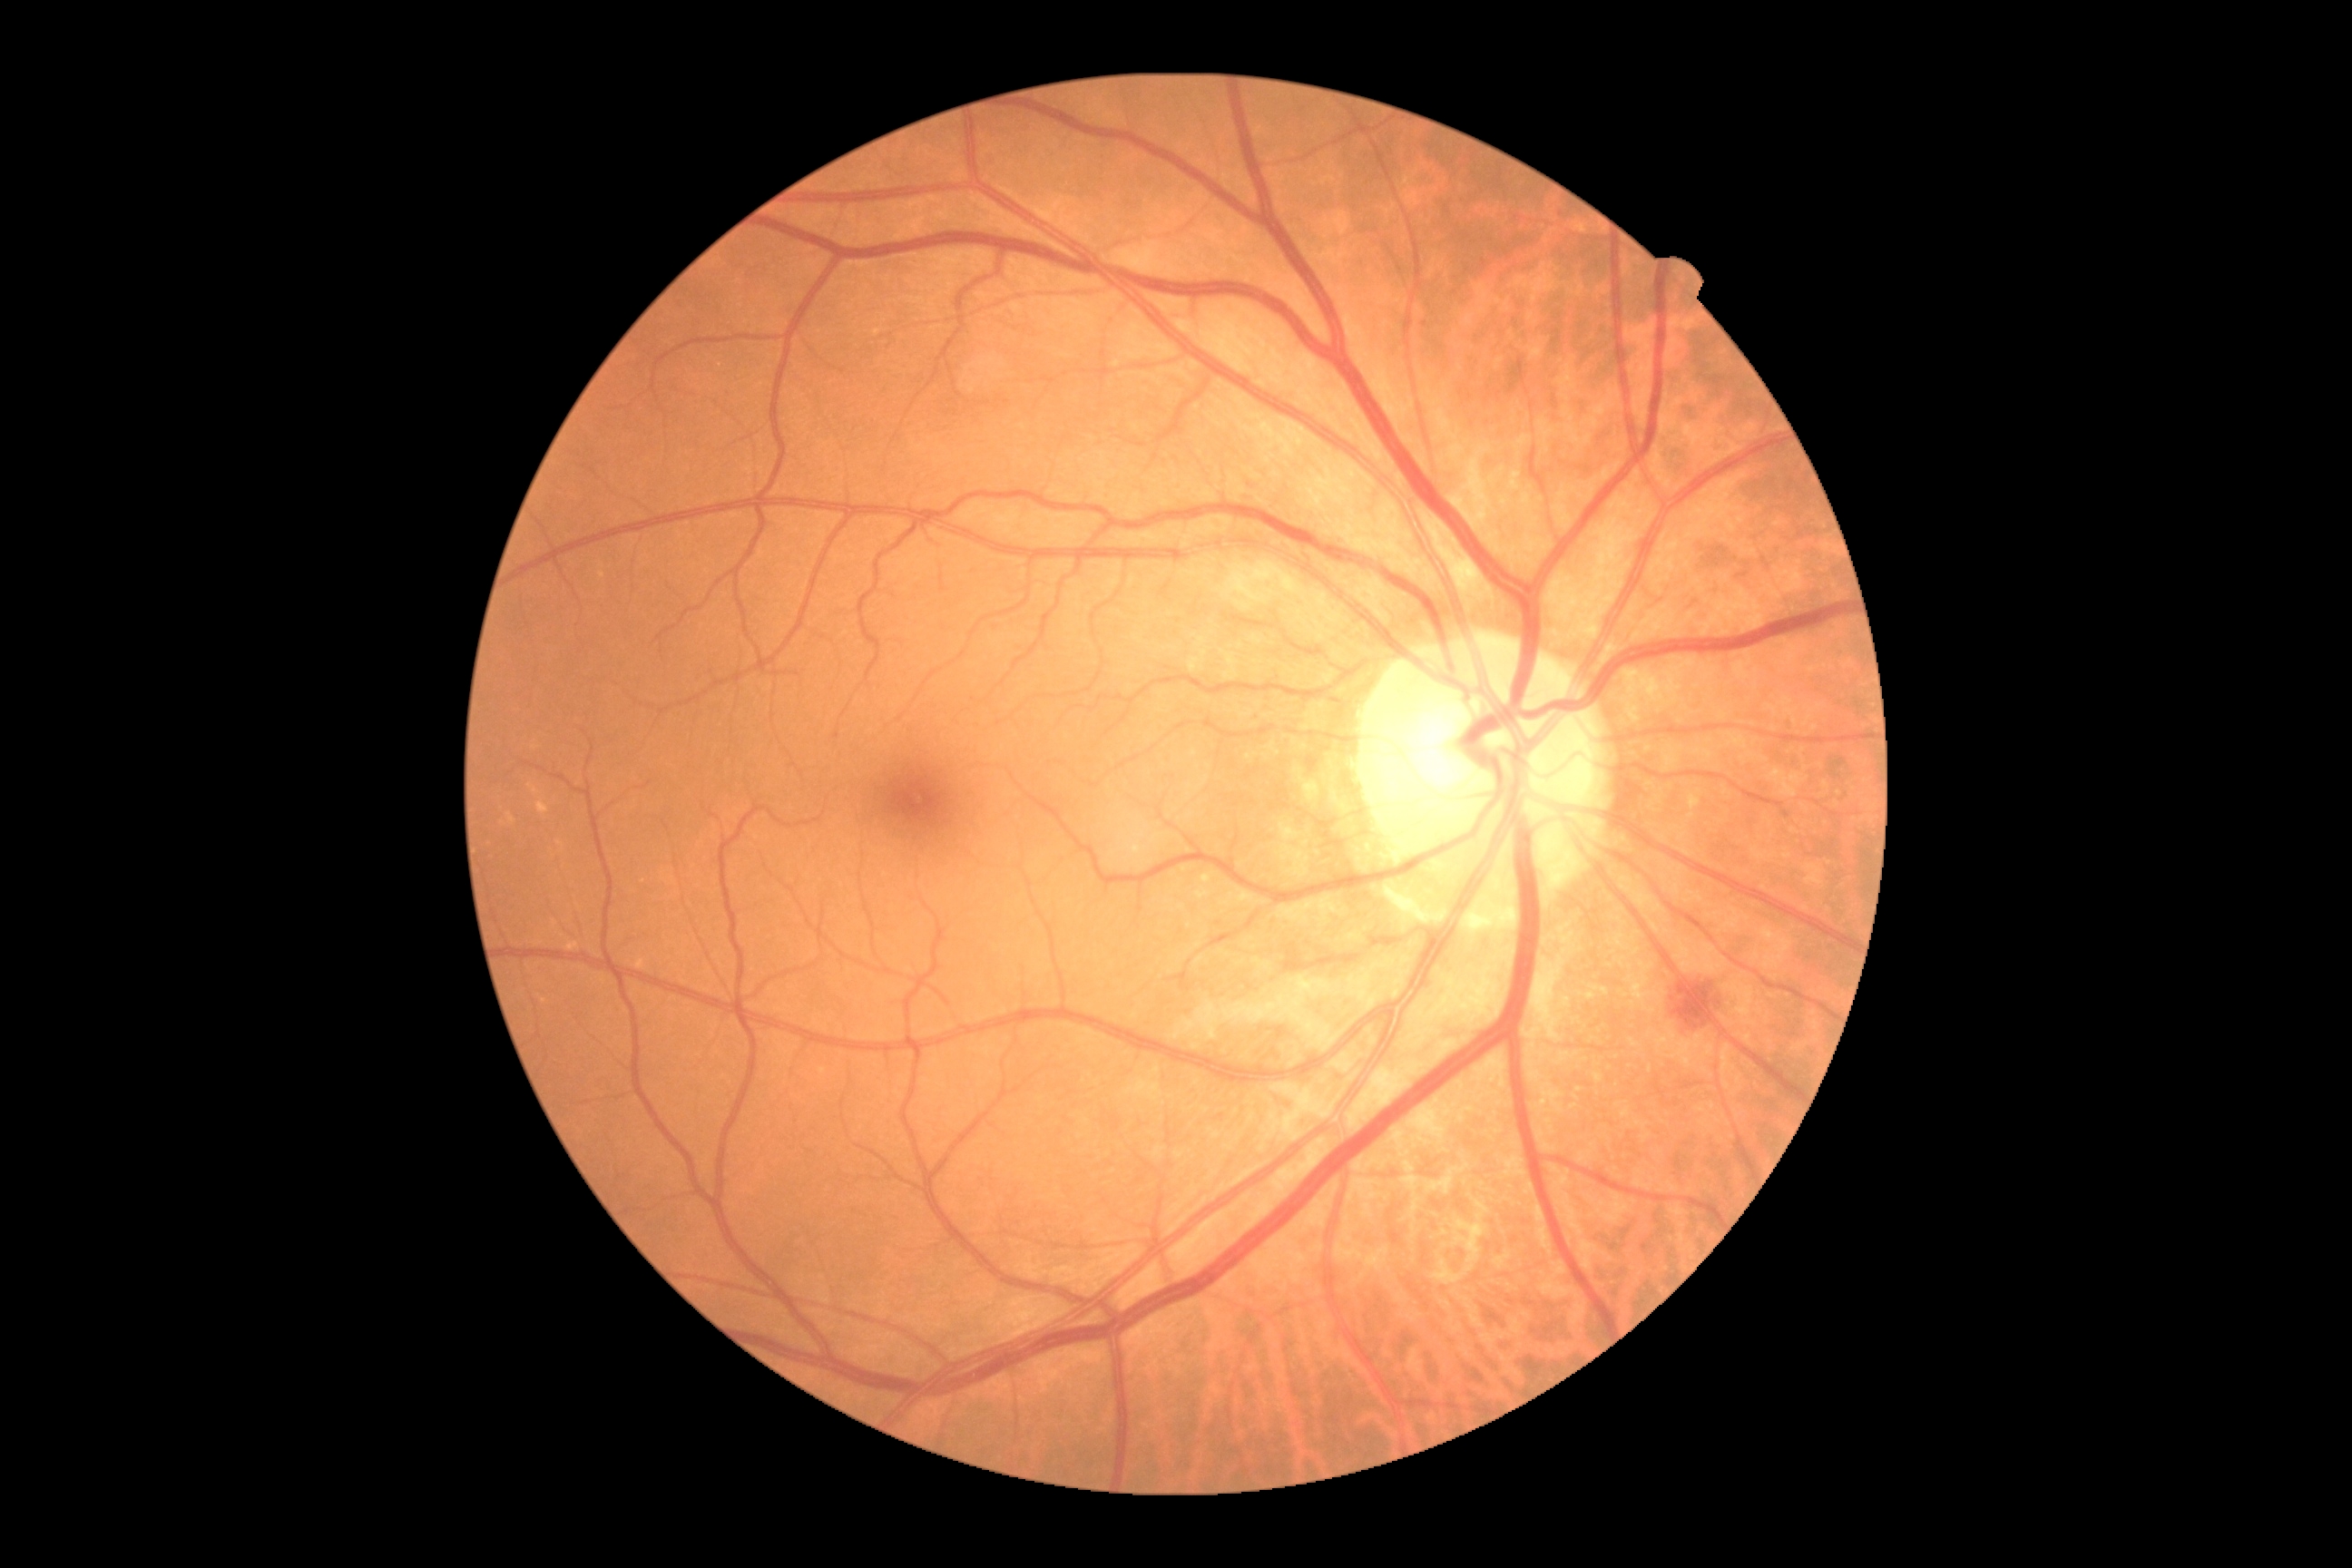
DR severity: 2.